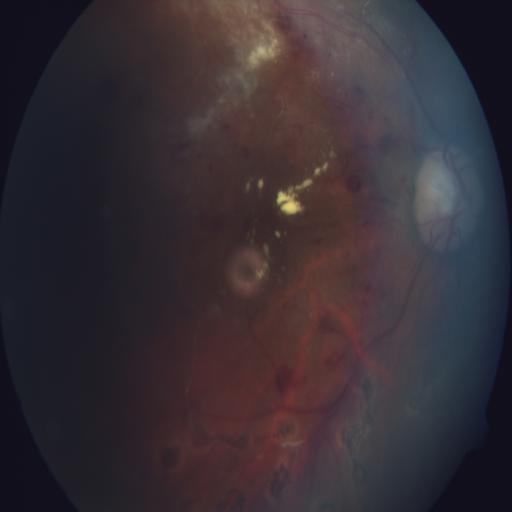 Findings: hemorrhagic retinopathy (HR); cotton wool spots (CWS).